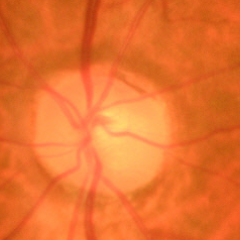
Early glaucoma.
Diagnostic criteria: glaucomatous retinal nerve fiber layer defects on red-free fundus photography without visual field defects.